Image size 1659x2212 — 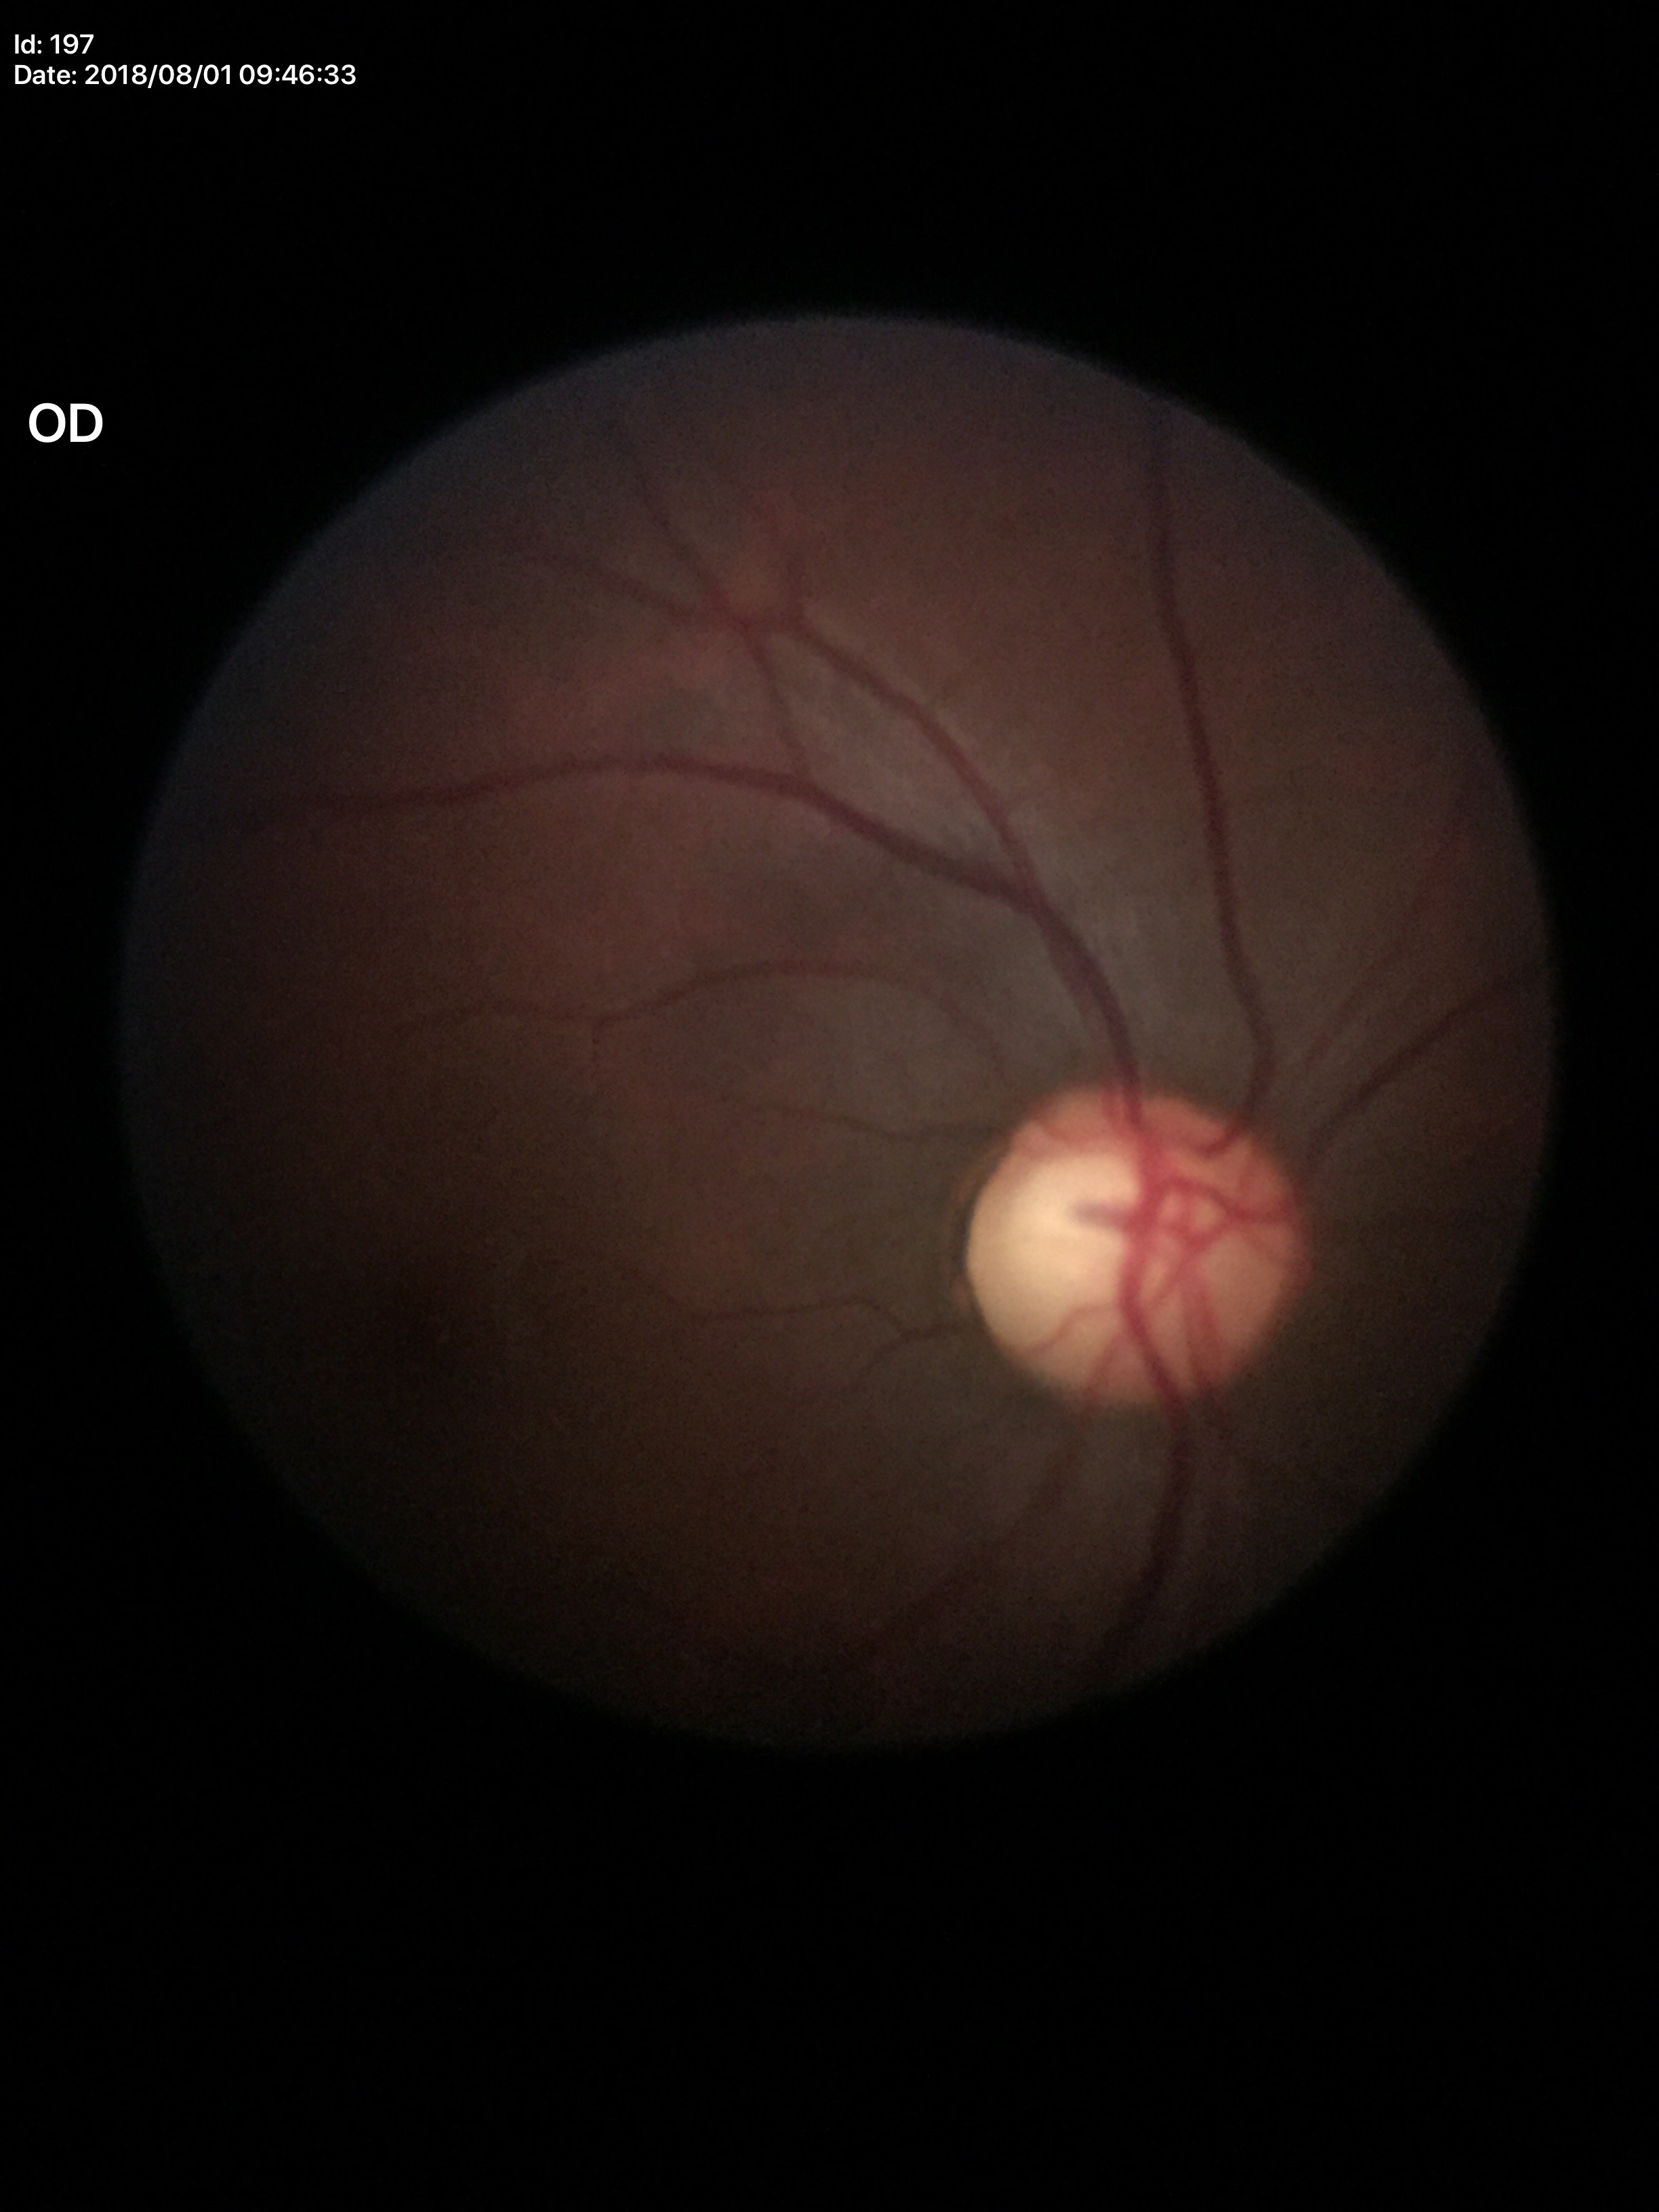
Glaucoma screening impression: suspicious findings
vertical cup-disc ratio (VCDR): 0.62